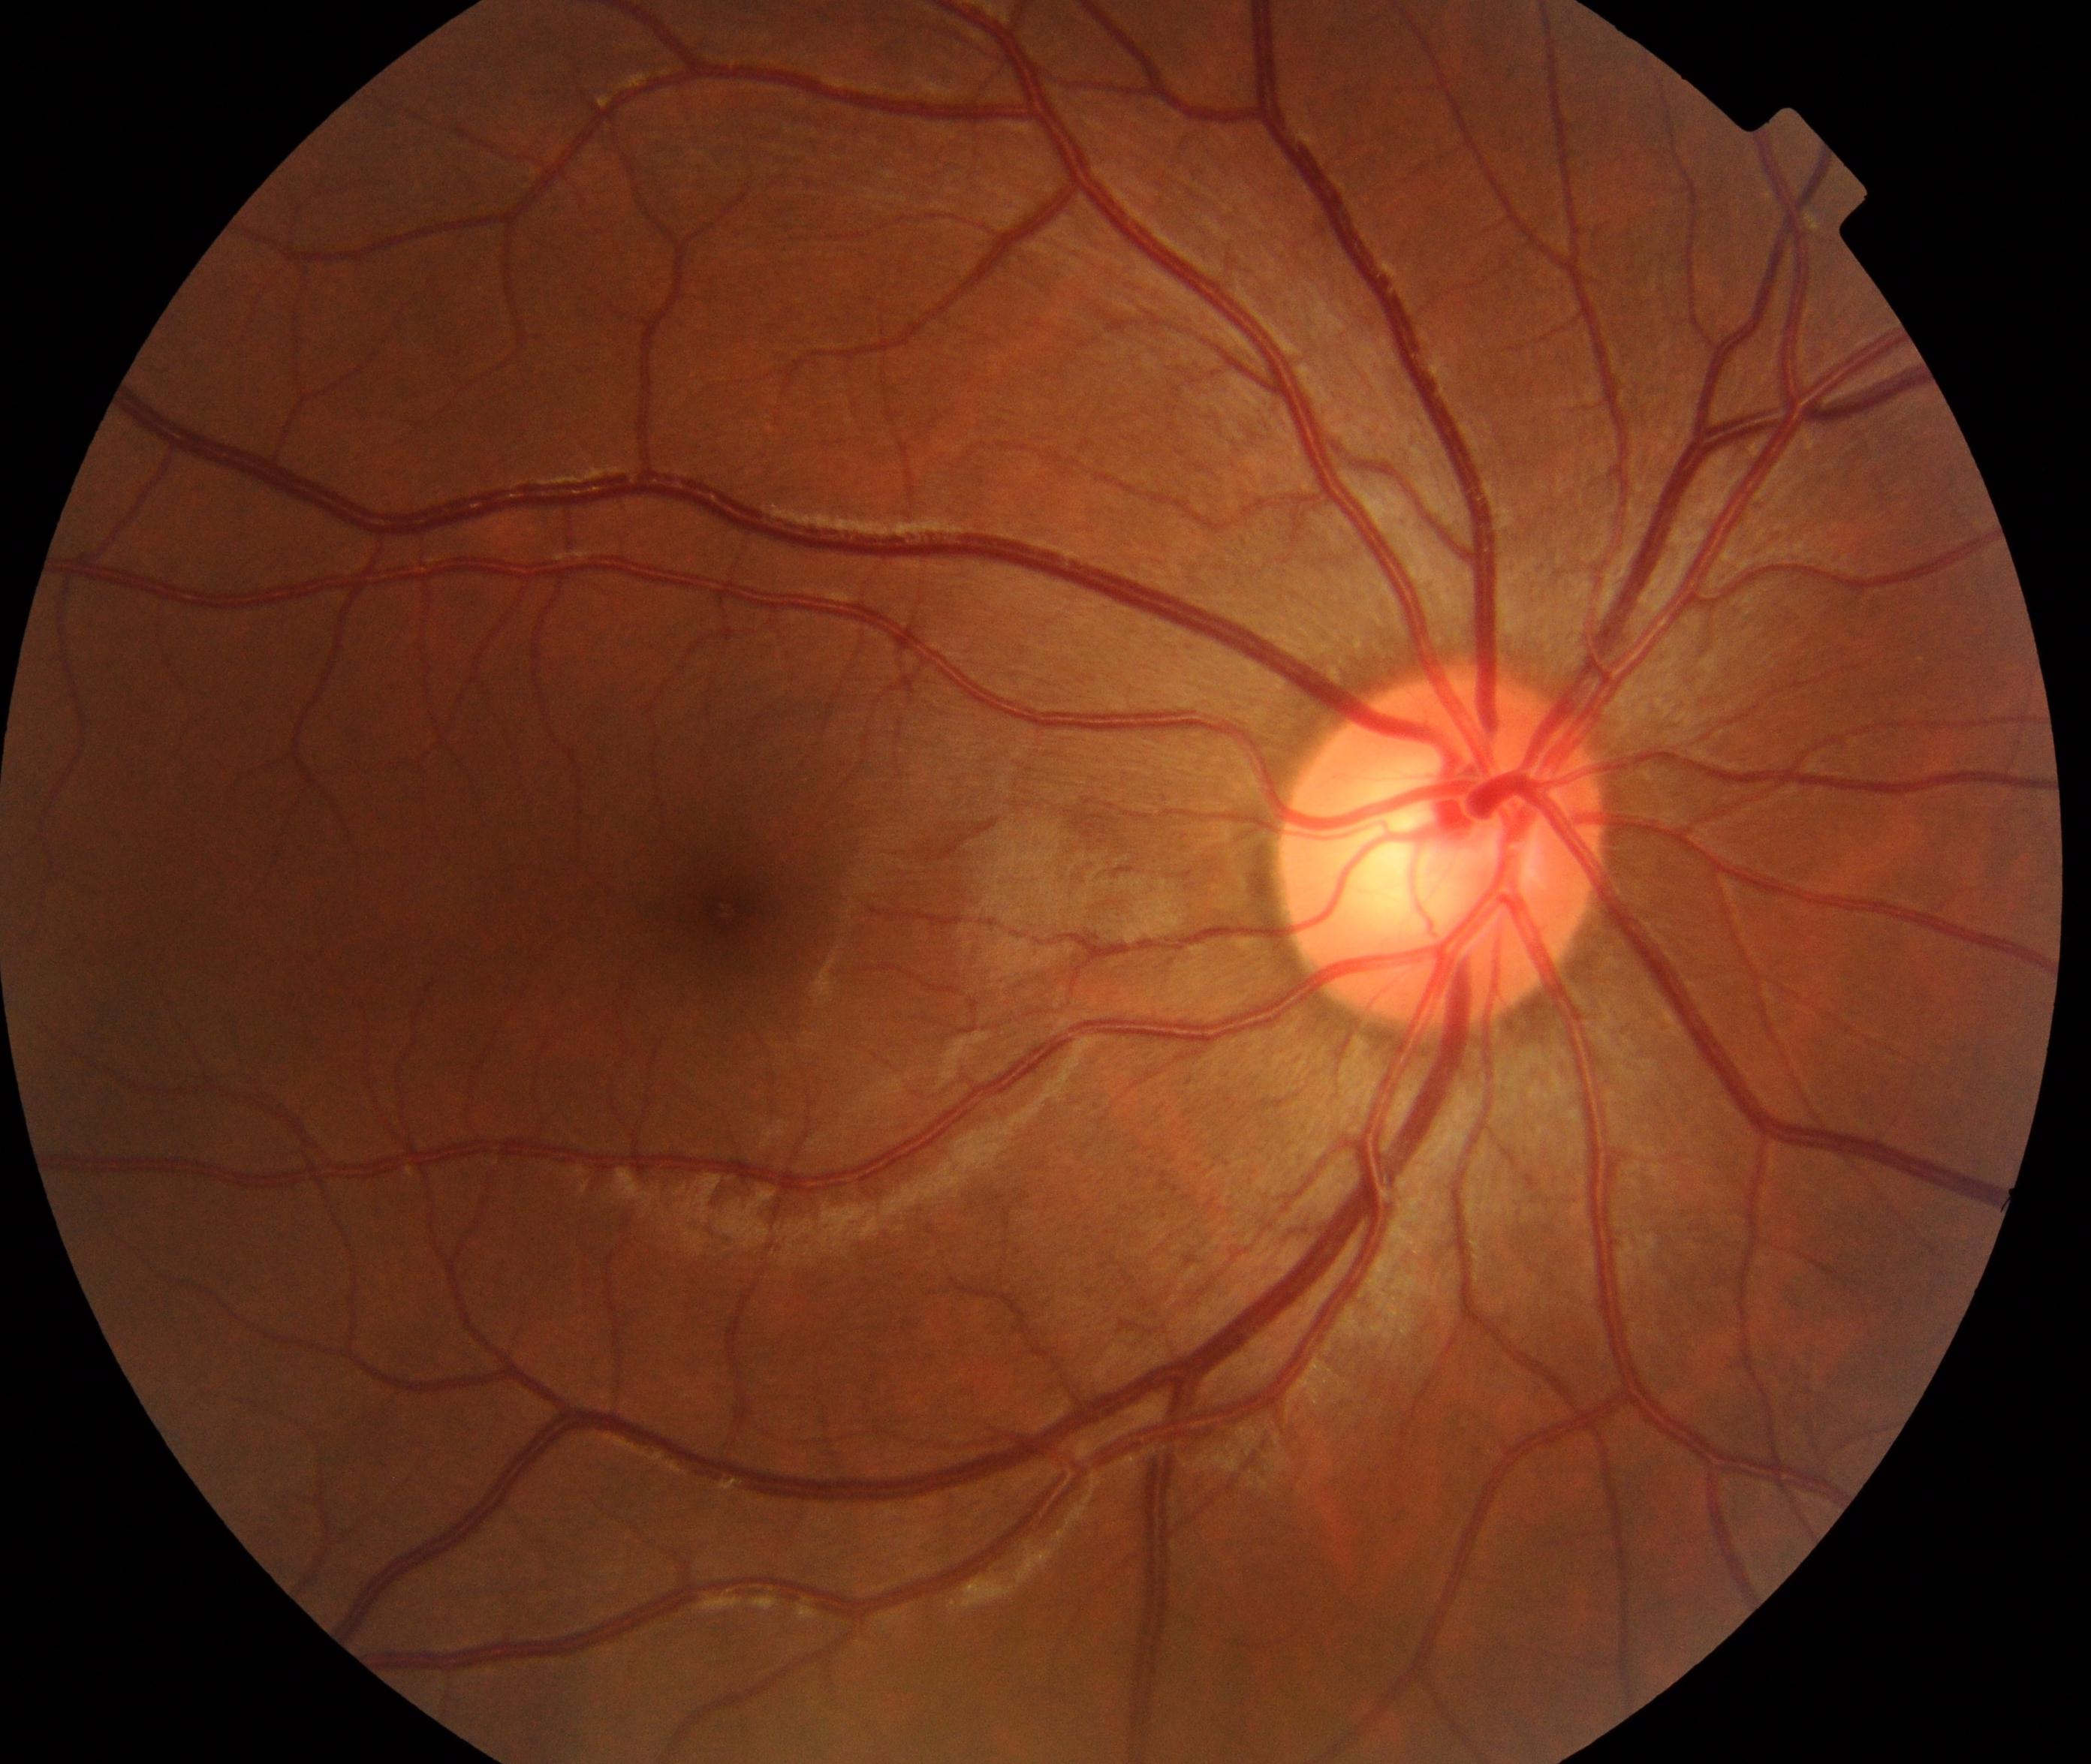
Findings: no abnormalities.